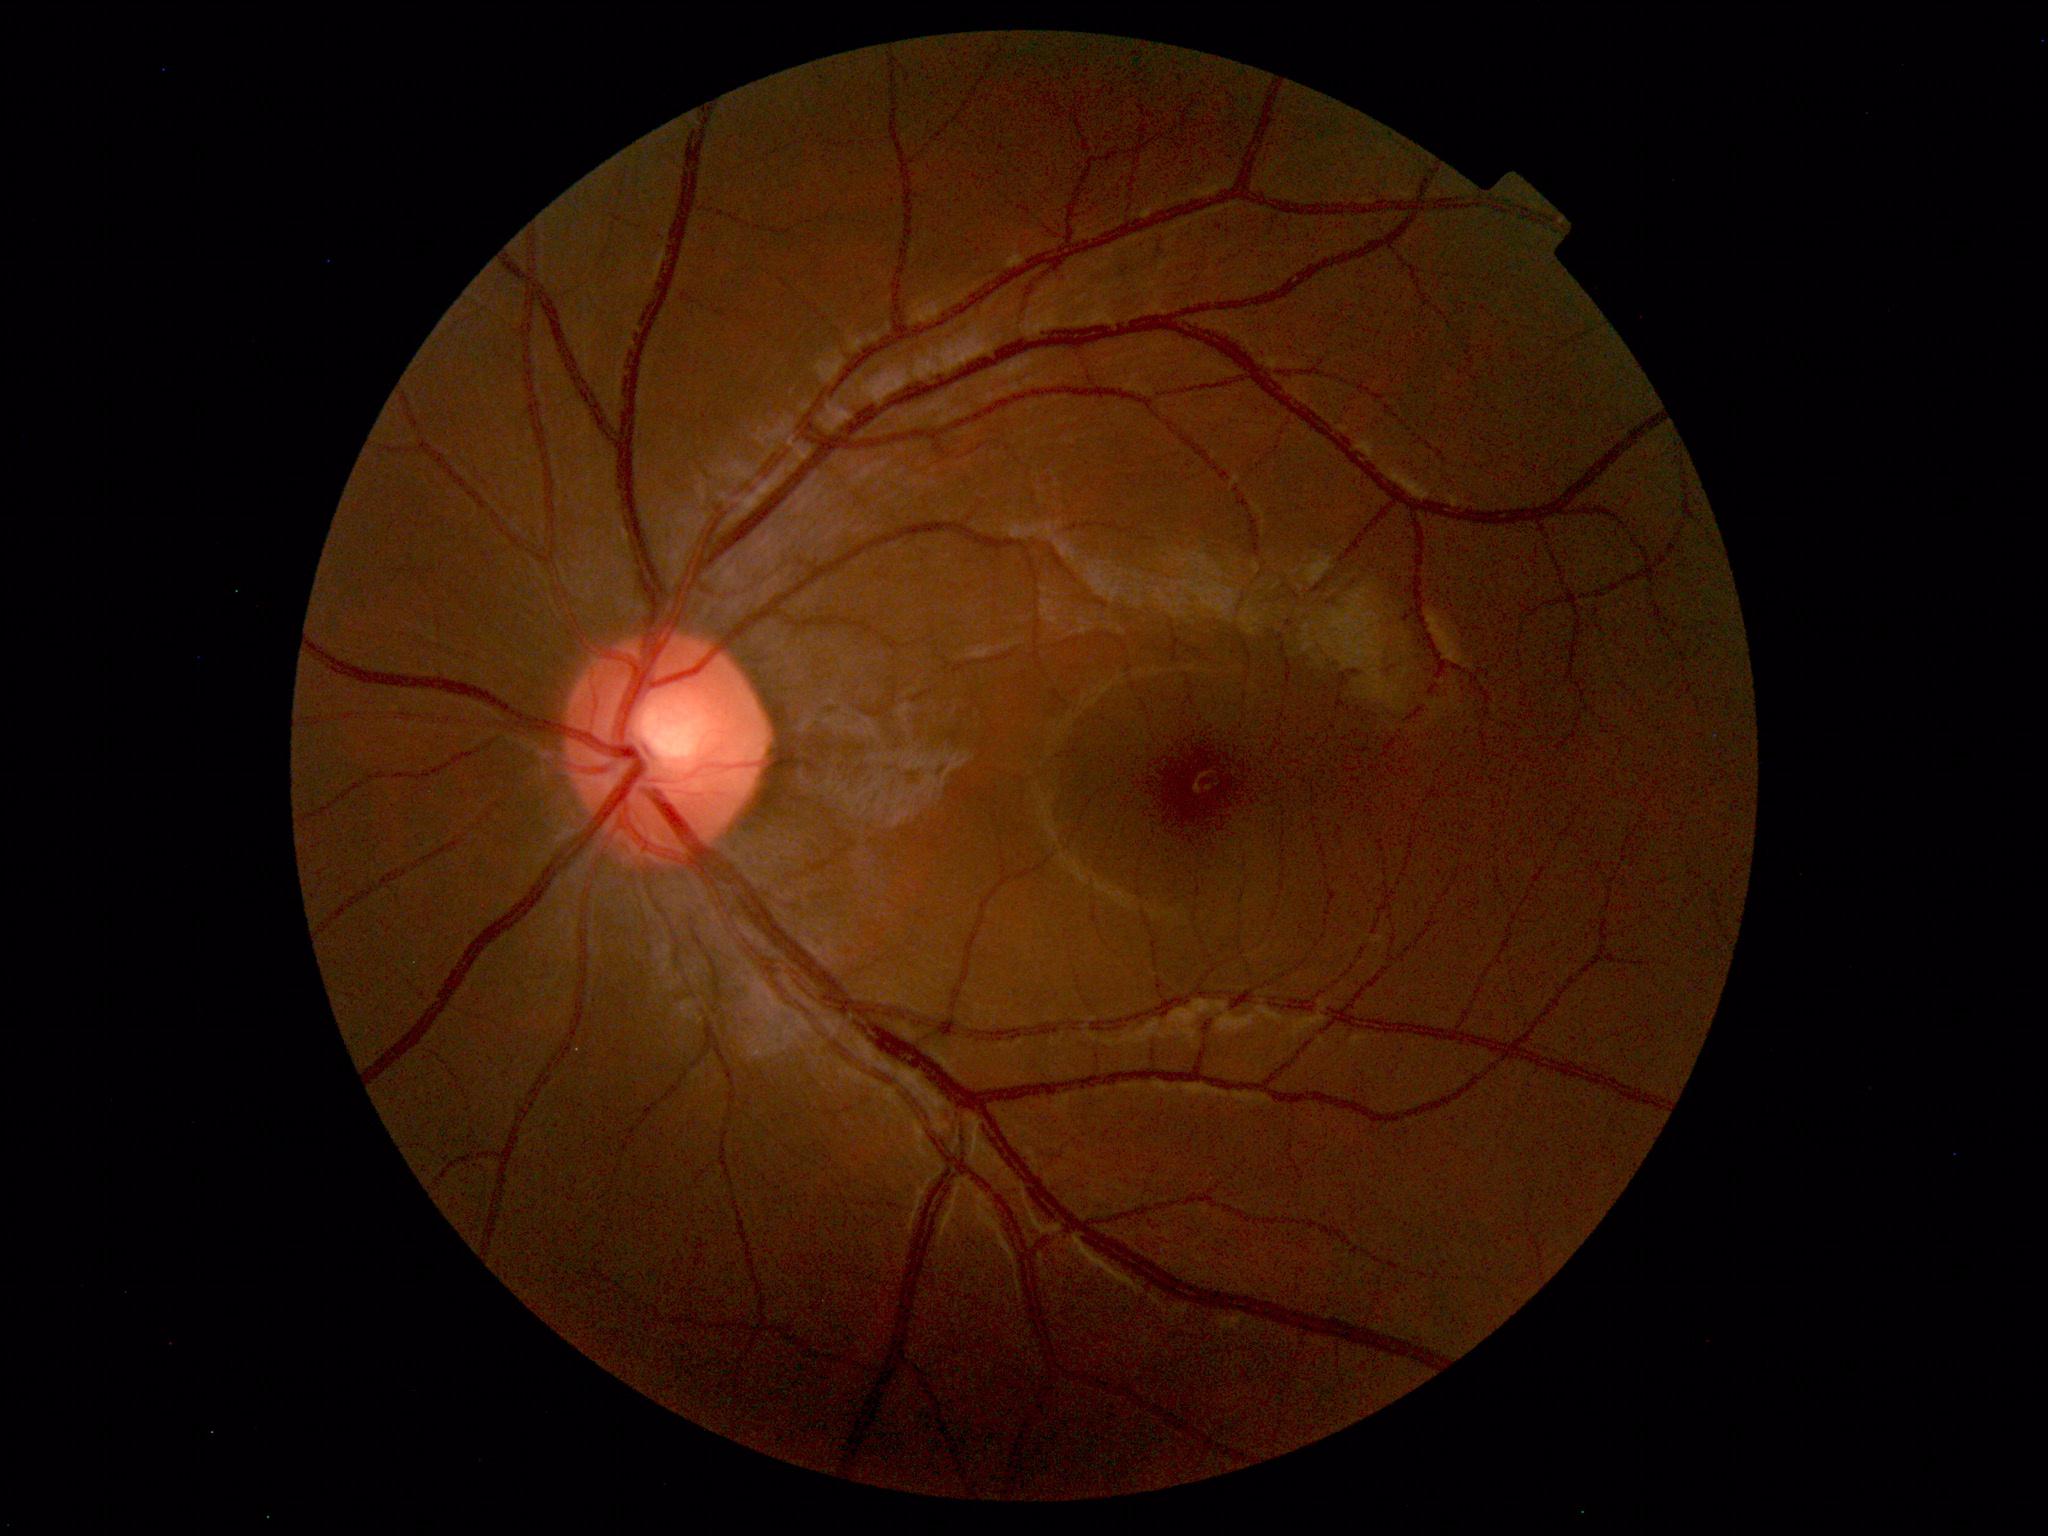

Impression: within normal limits.